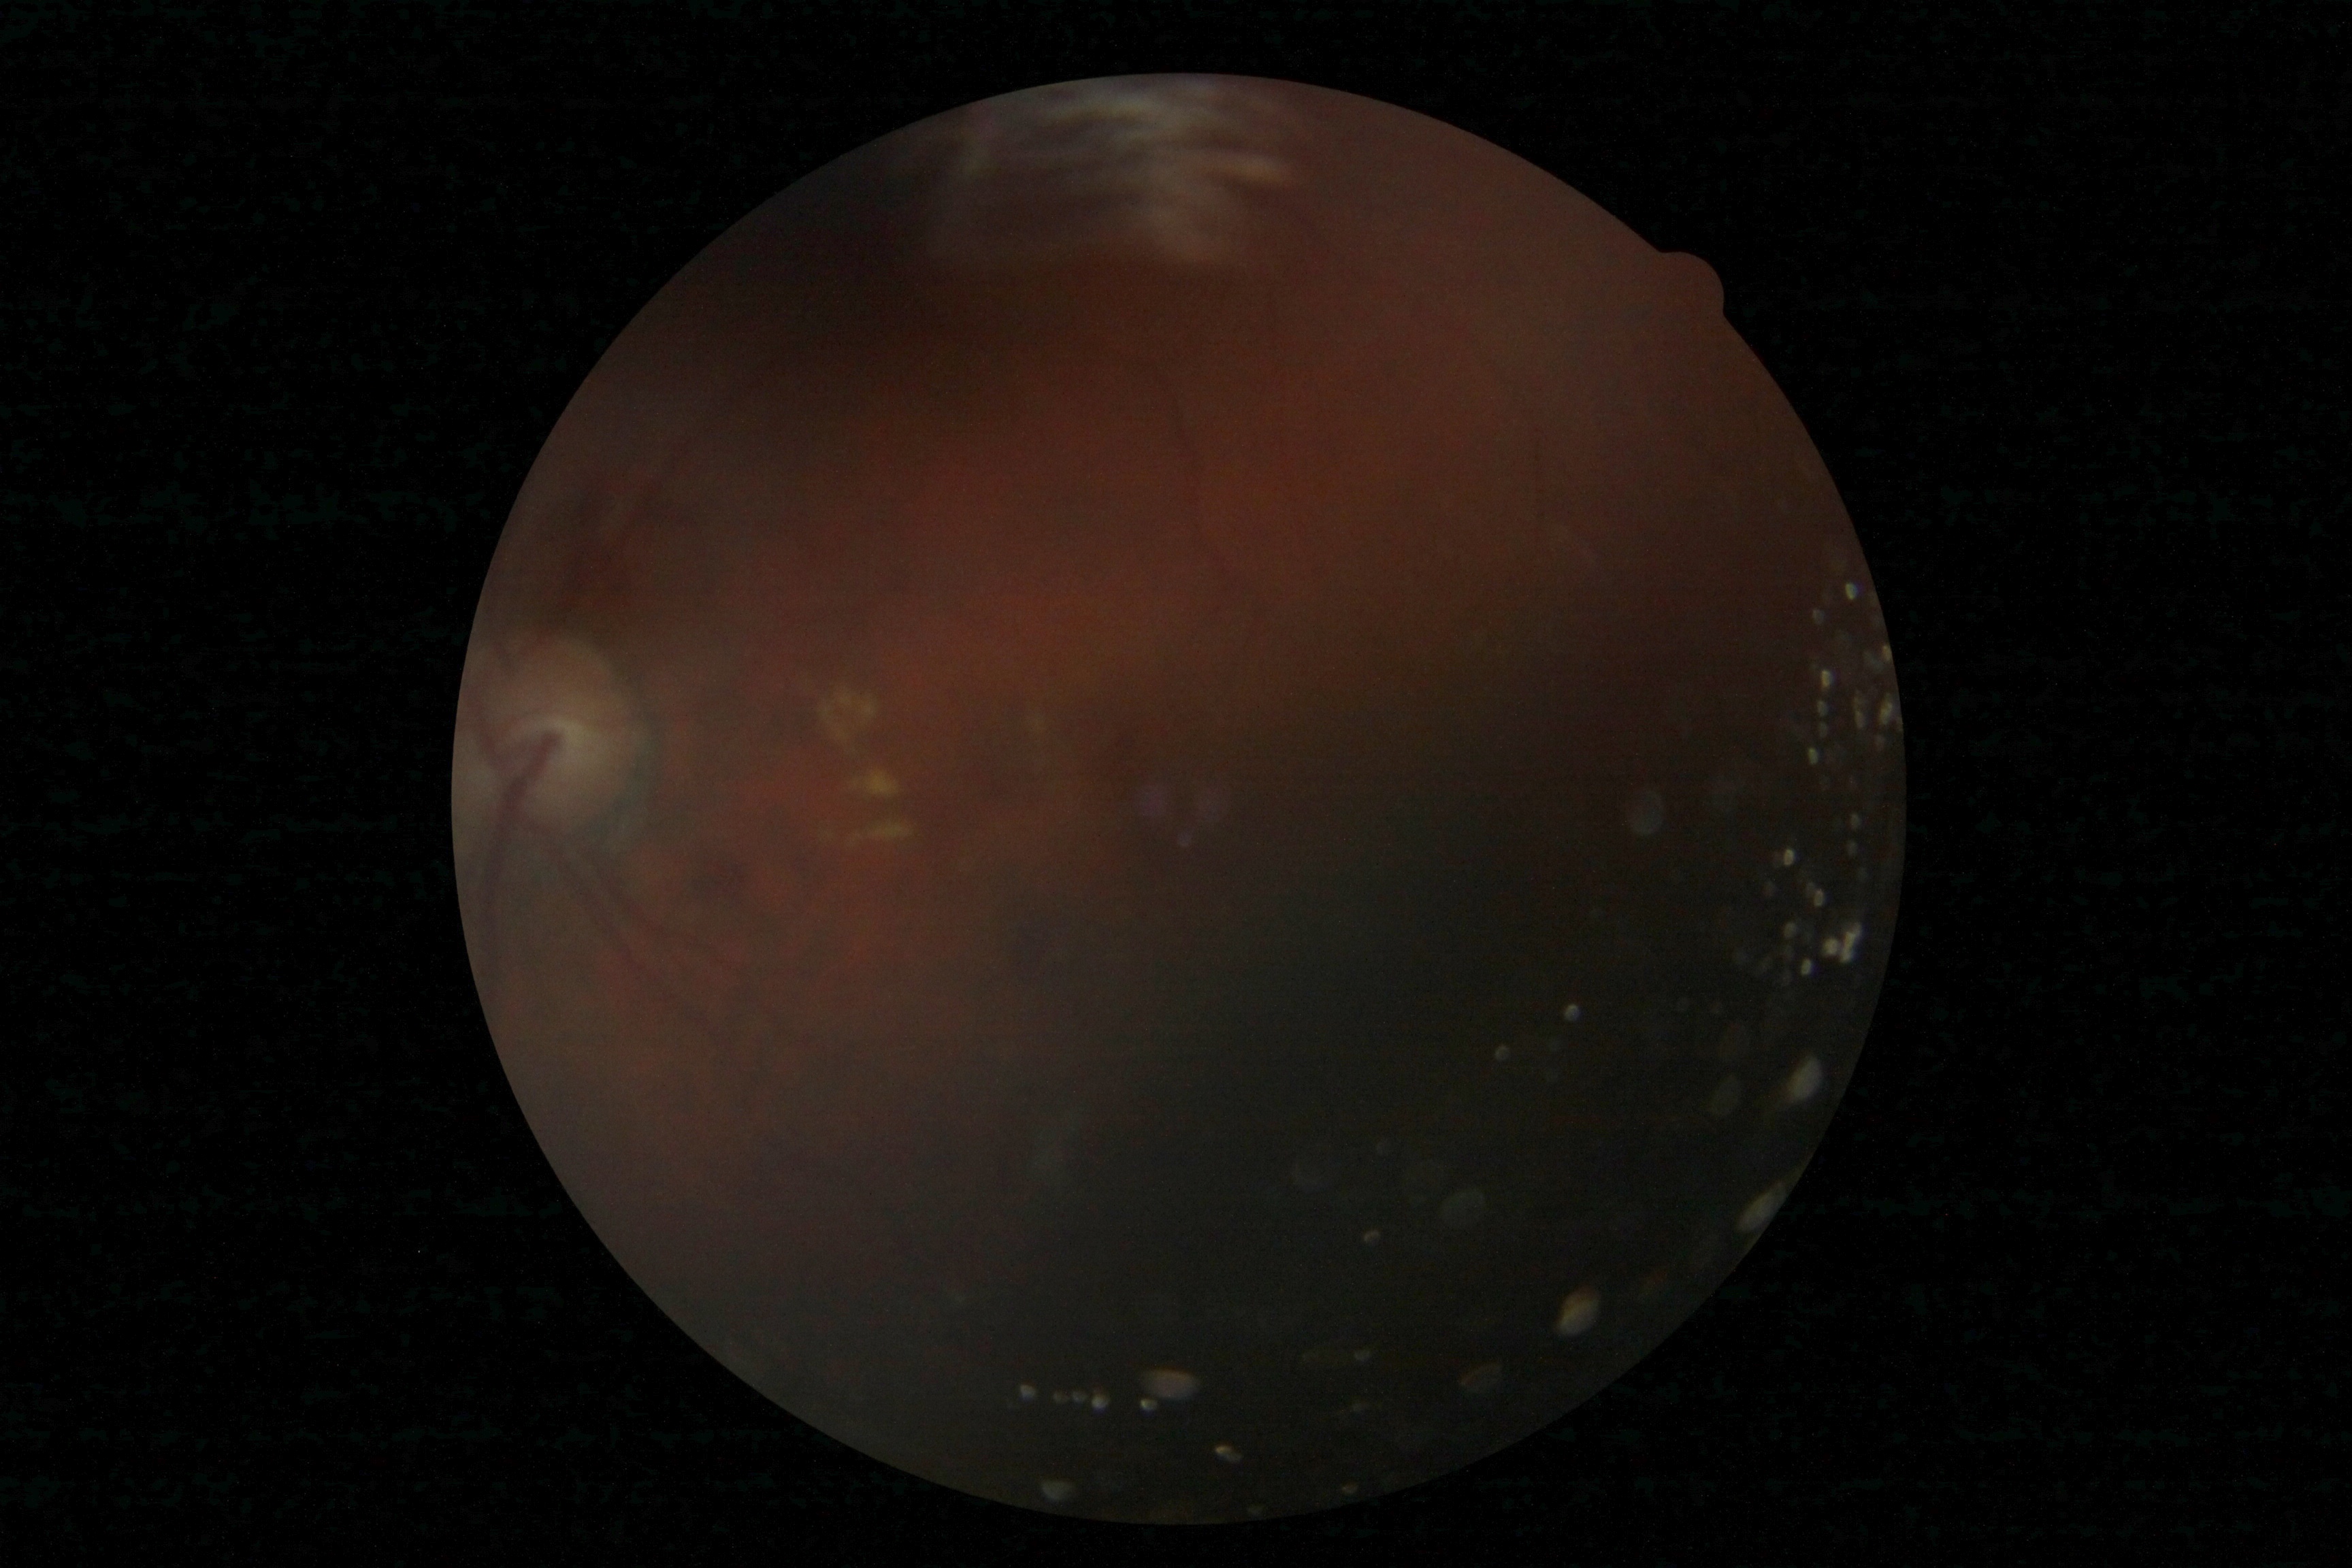
Diabetic retinopathy (DR) is grade 2 (moderate NPDR).